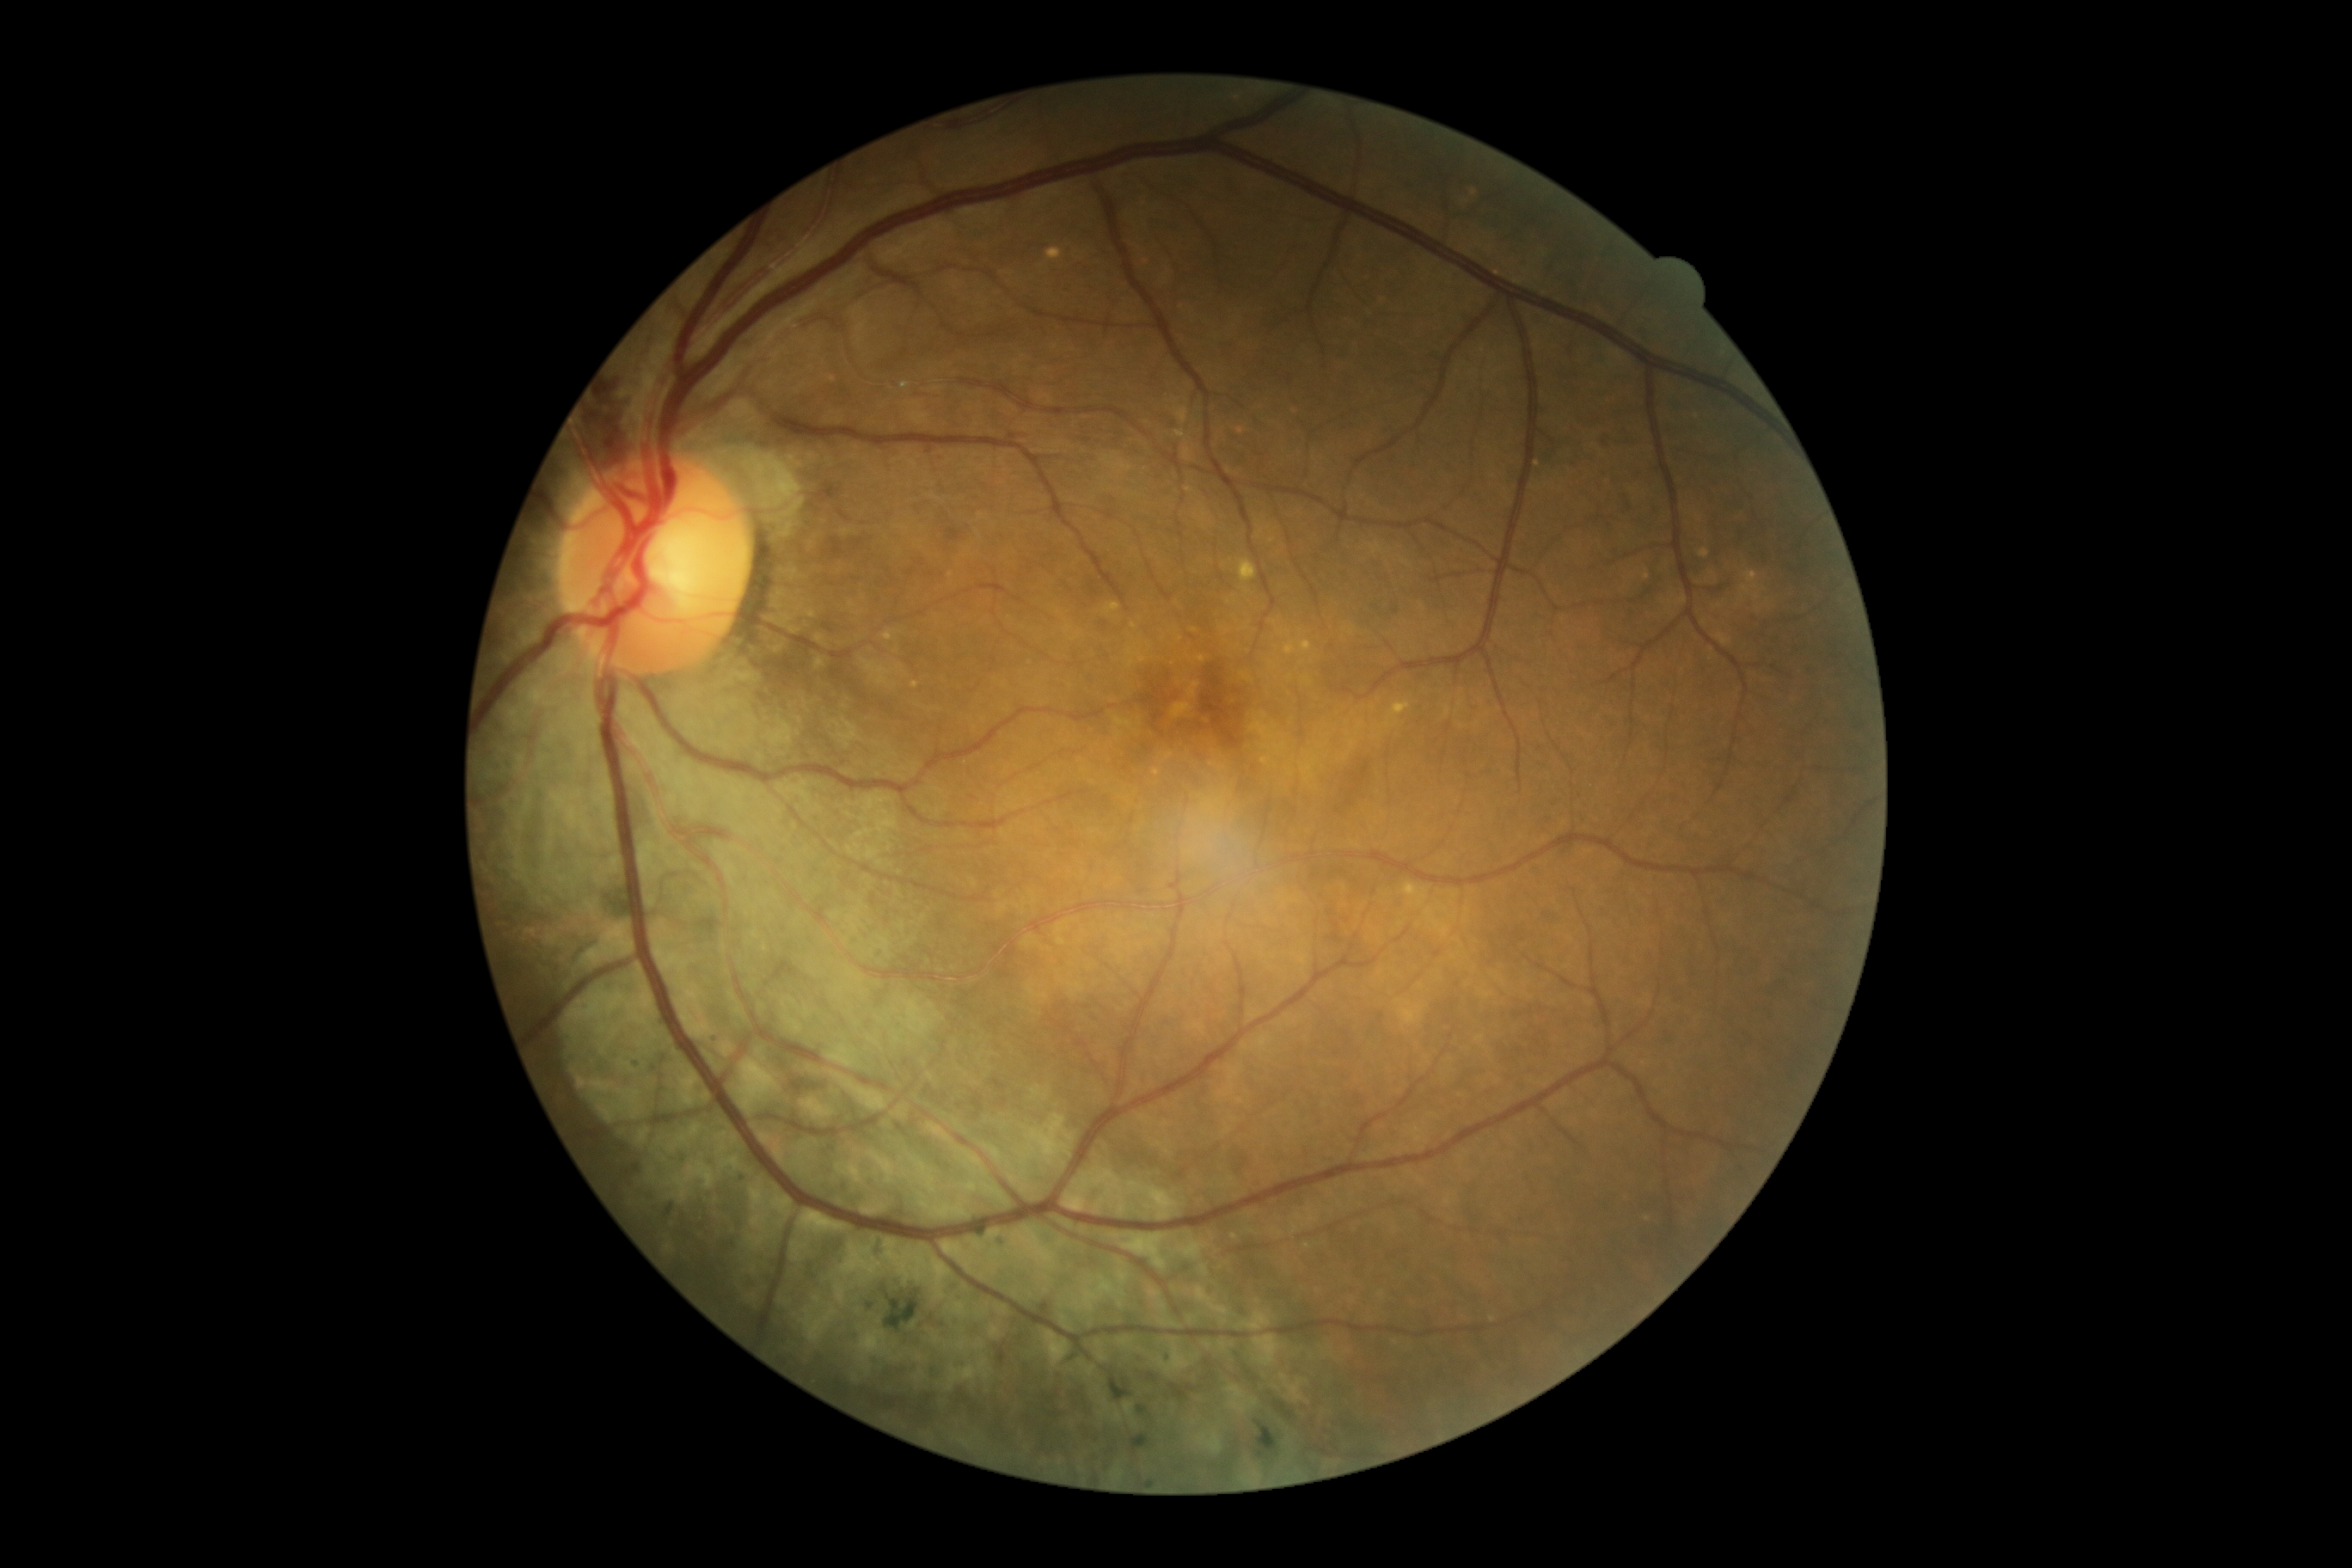
Diabetic retinopathy (DR): grade 3 (severe NPDR) — more than 20 intraretinal hemorrhages in each of 4 quadrants, definite venous beading in 2 or more quadrants, or prominent intraretinal microvascular abnormalities in 1 or more quadrants, with no signs of proliferative retinopathy.